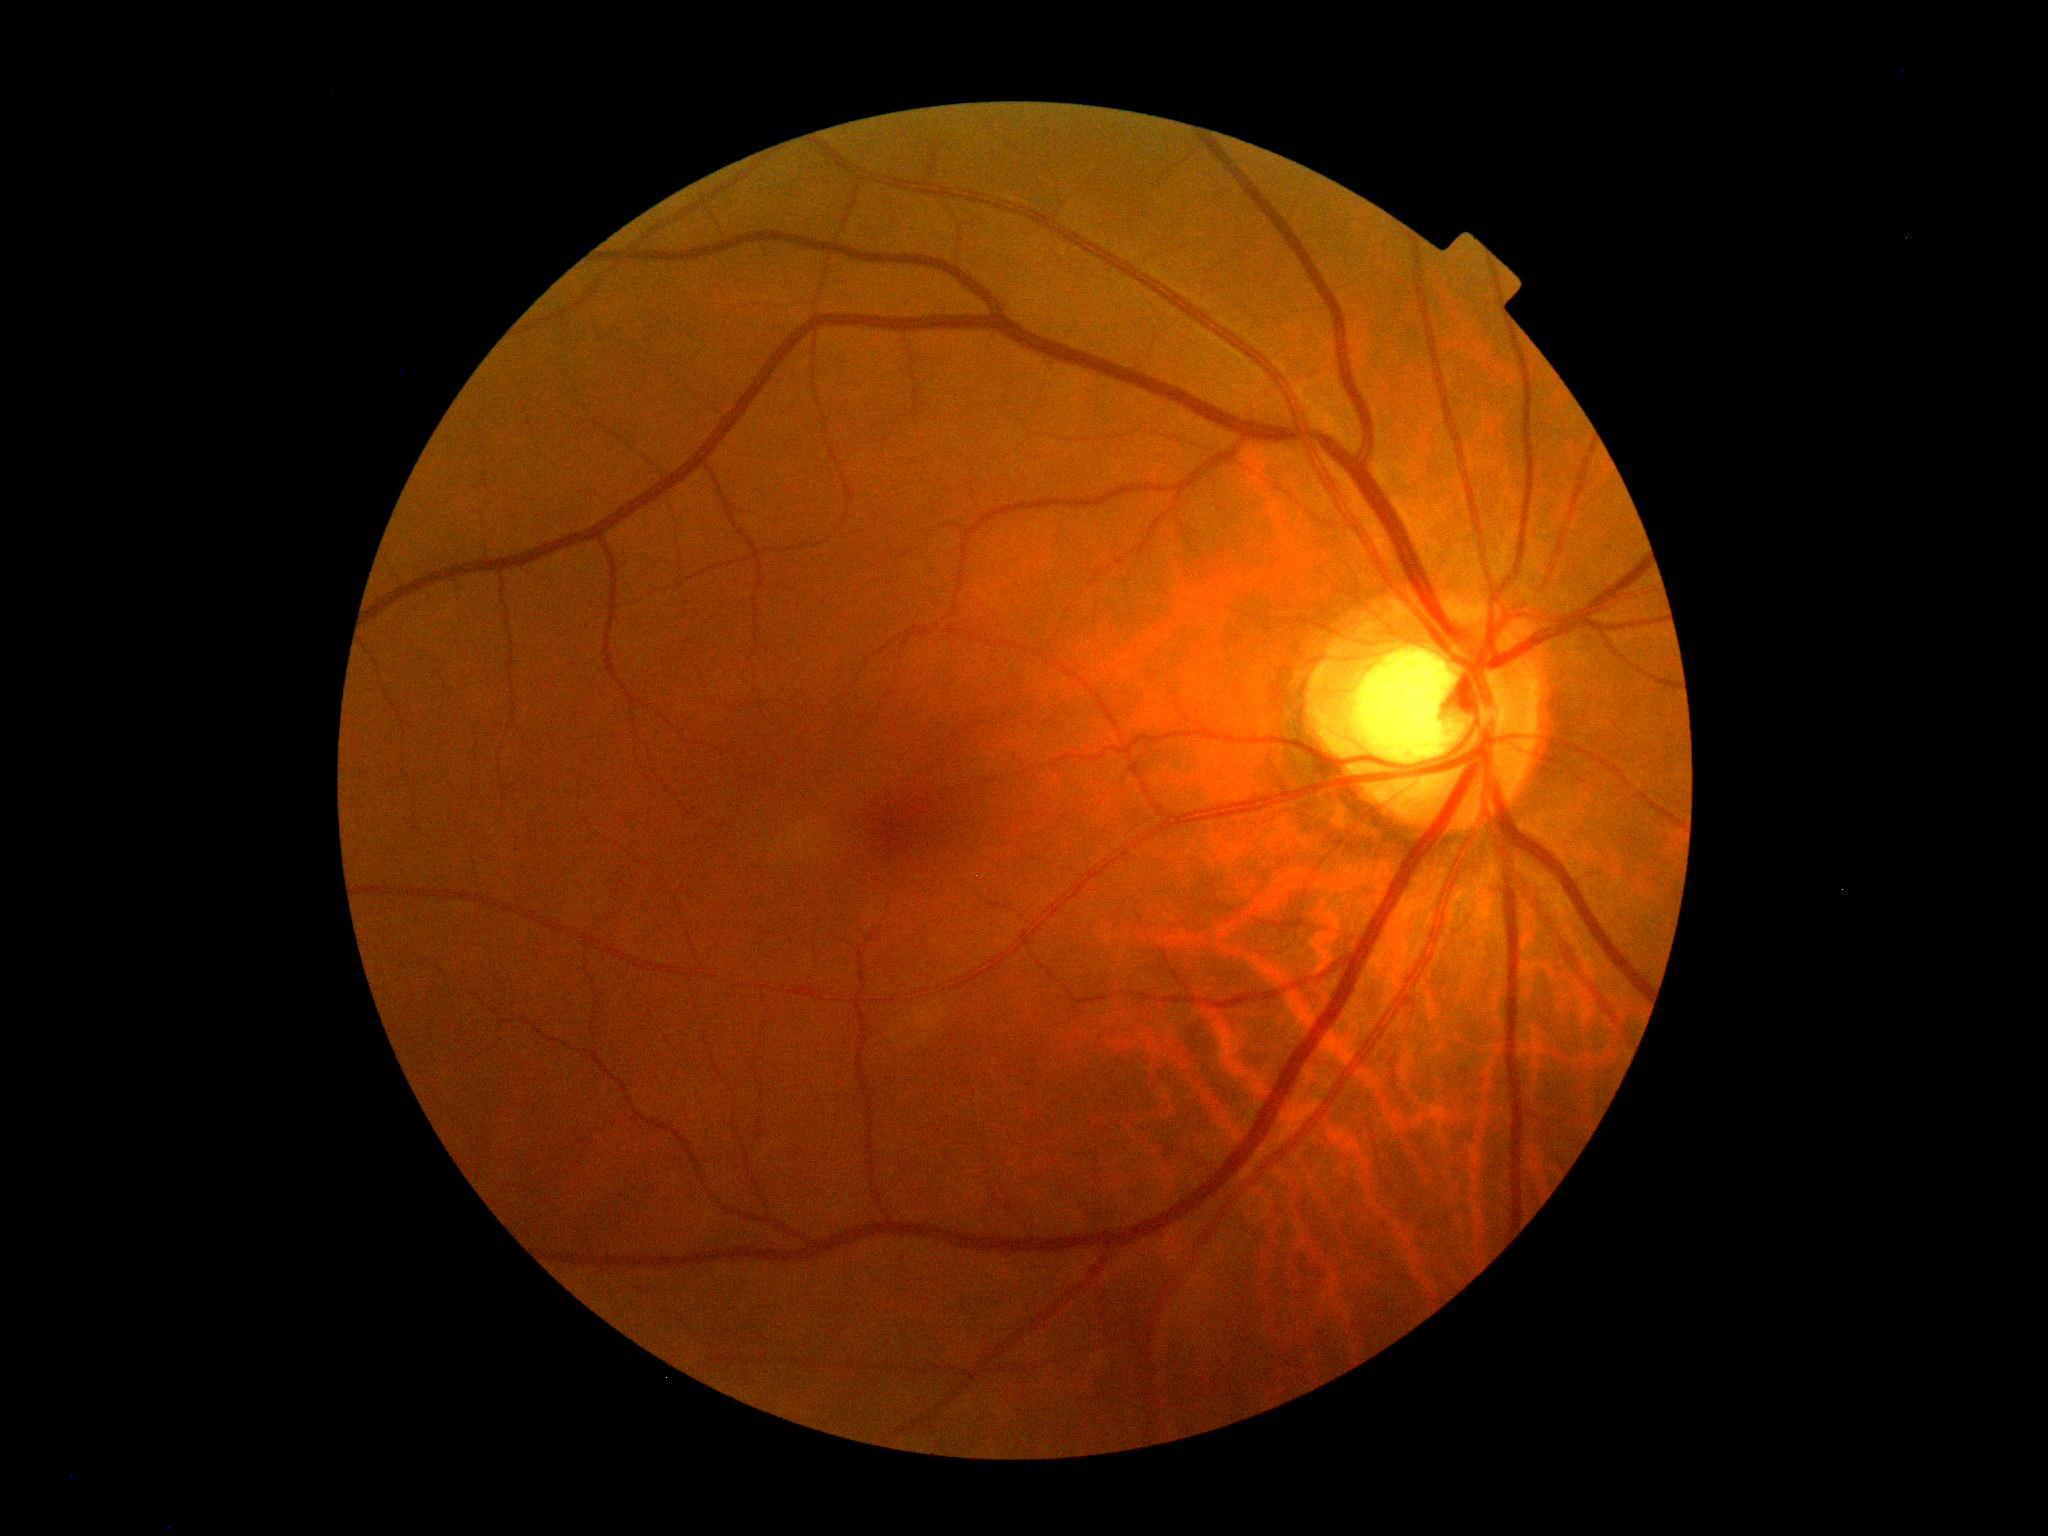

No signs of diabetic retinopathy. Retinopathy: 0/4.